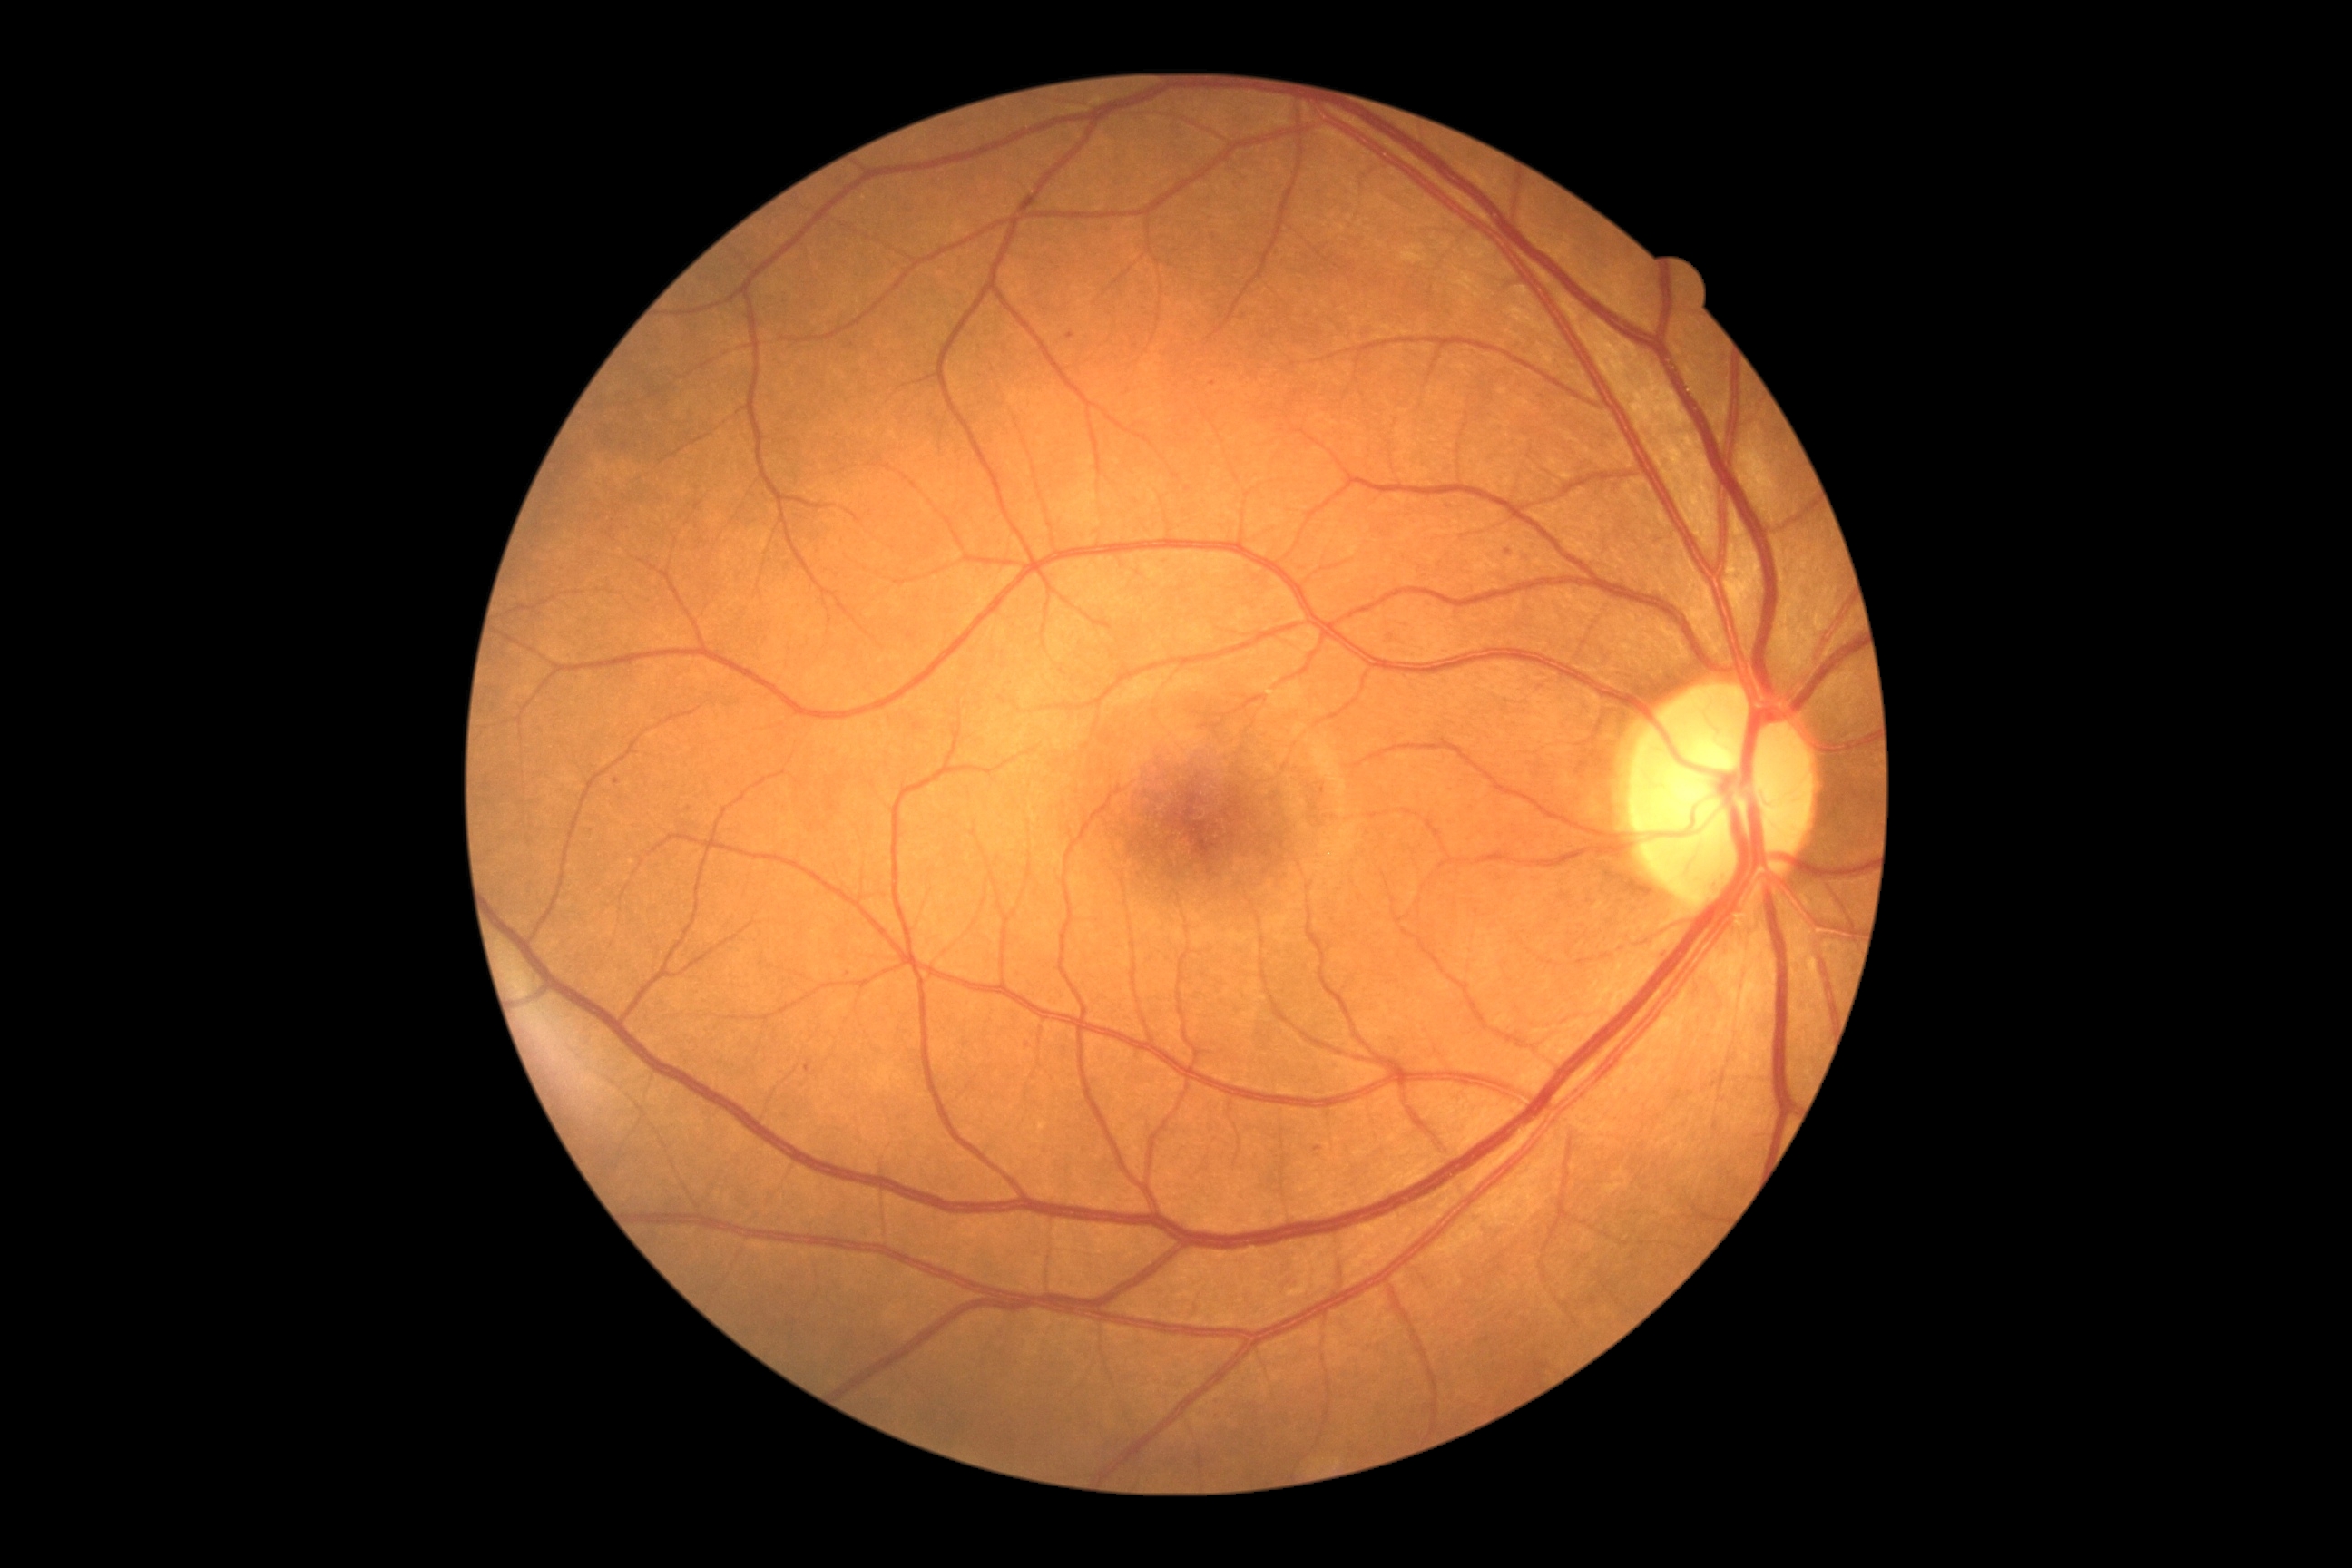 {"partial": true, "dr_grade": 1, "dr_grade_name": "mild NPDR", "lesions": {"se": null, "ma": [[805, 1059, 812, 1073], [1313, 1148, 1322, 1153]], "ma_small": [[1071, 336], [617, 781], [1214, 384], [1508, 551]], "he": null, "ex": null}}